Non-mydriatic: 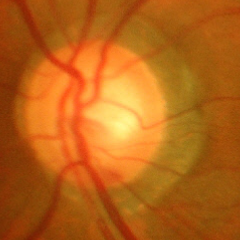
Advanced-stage glaucoma.